2212x1672; 45° FOV; fundus photo: 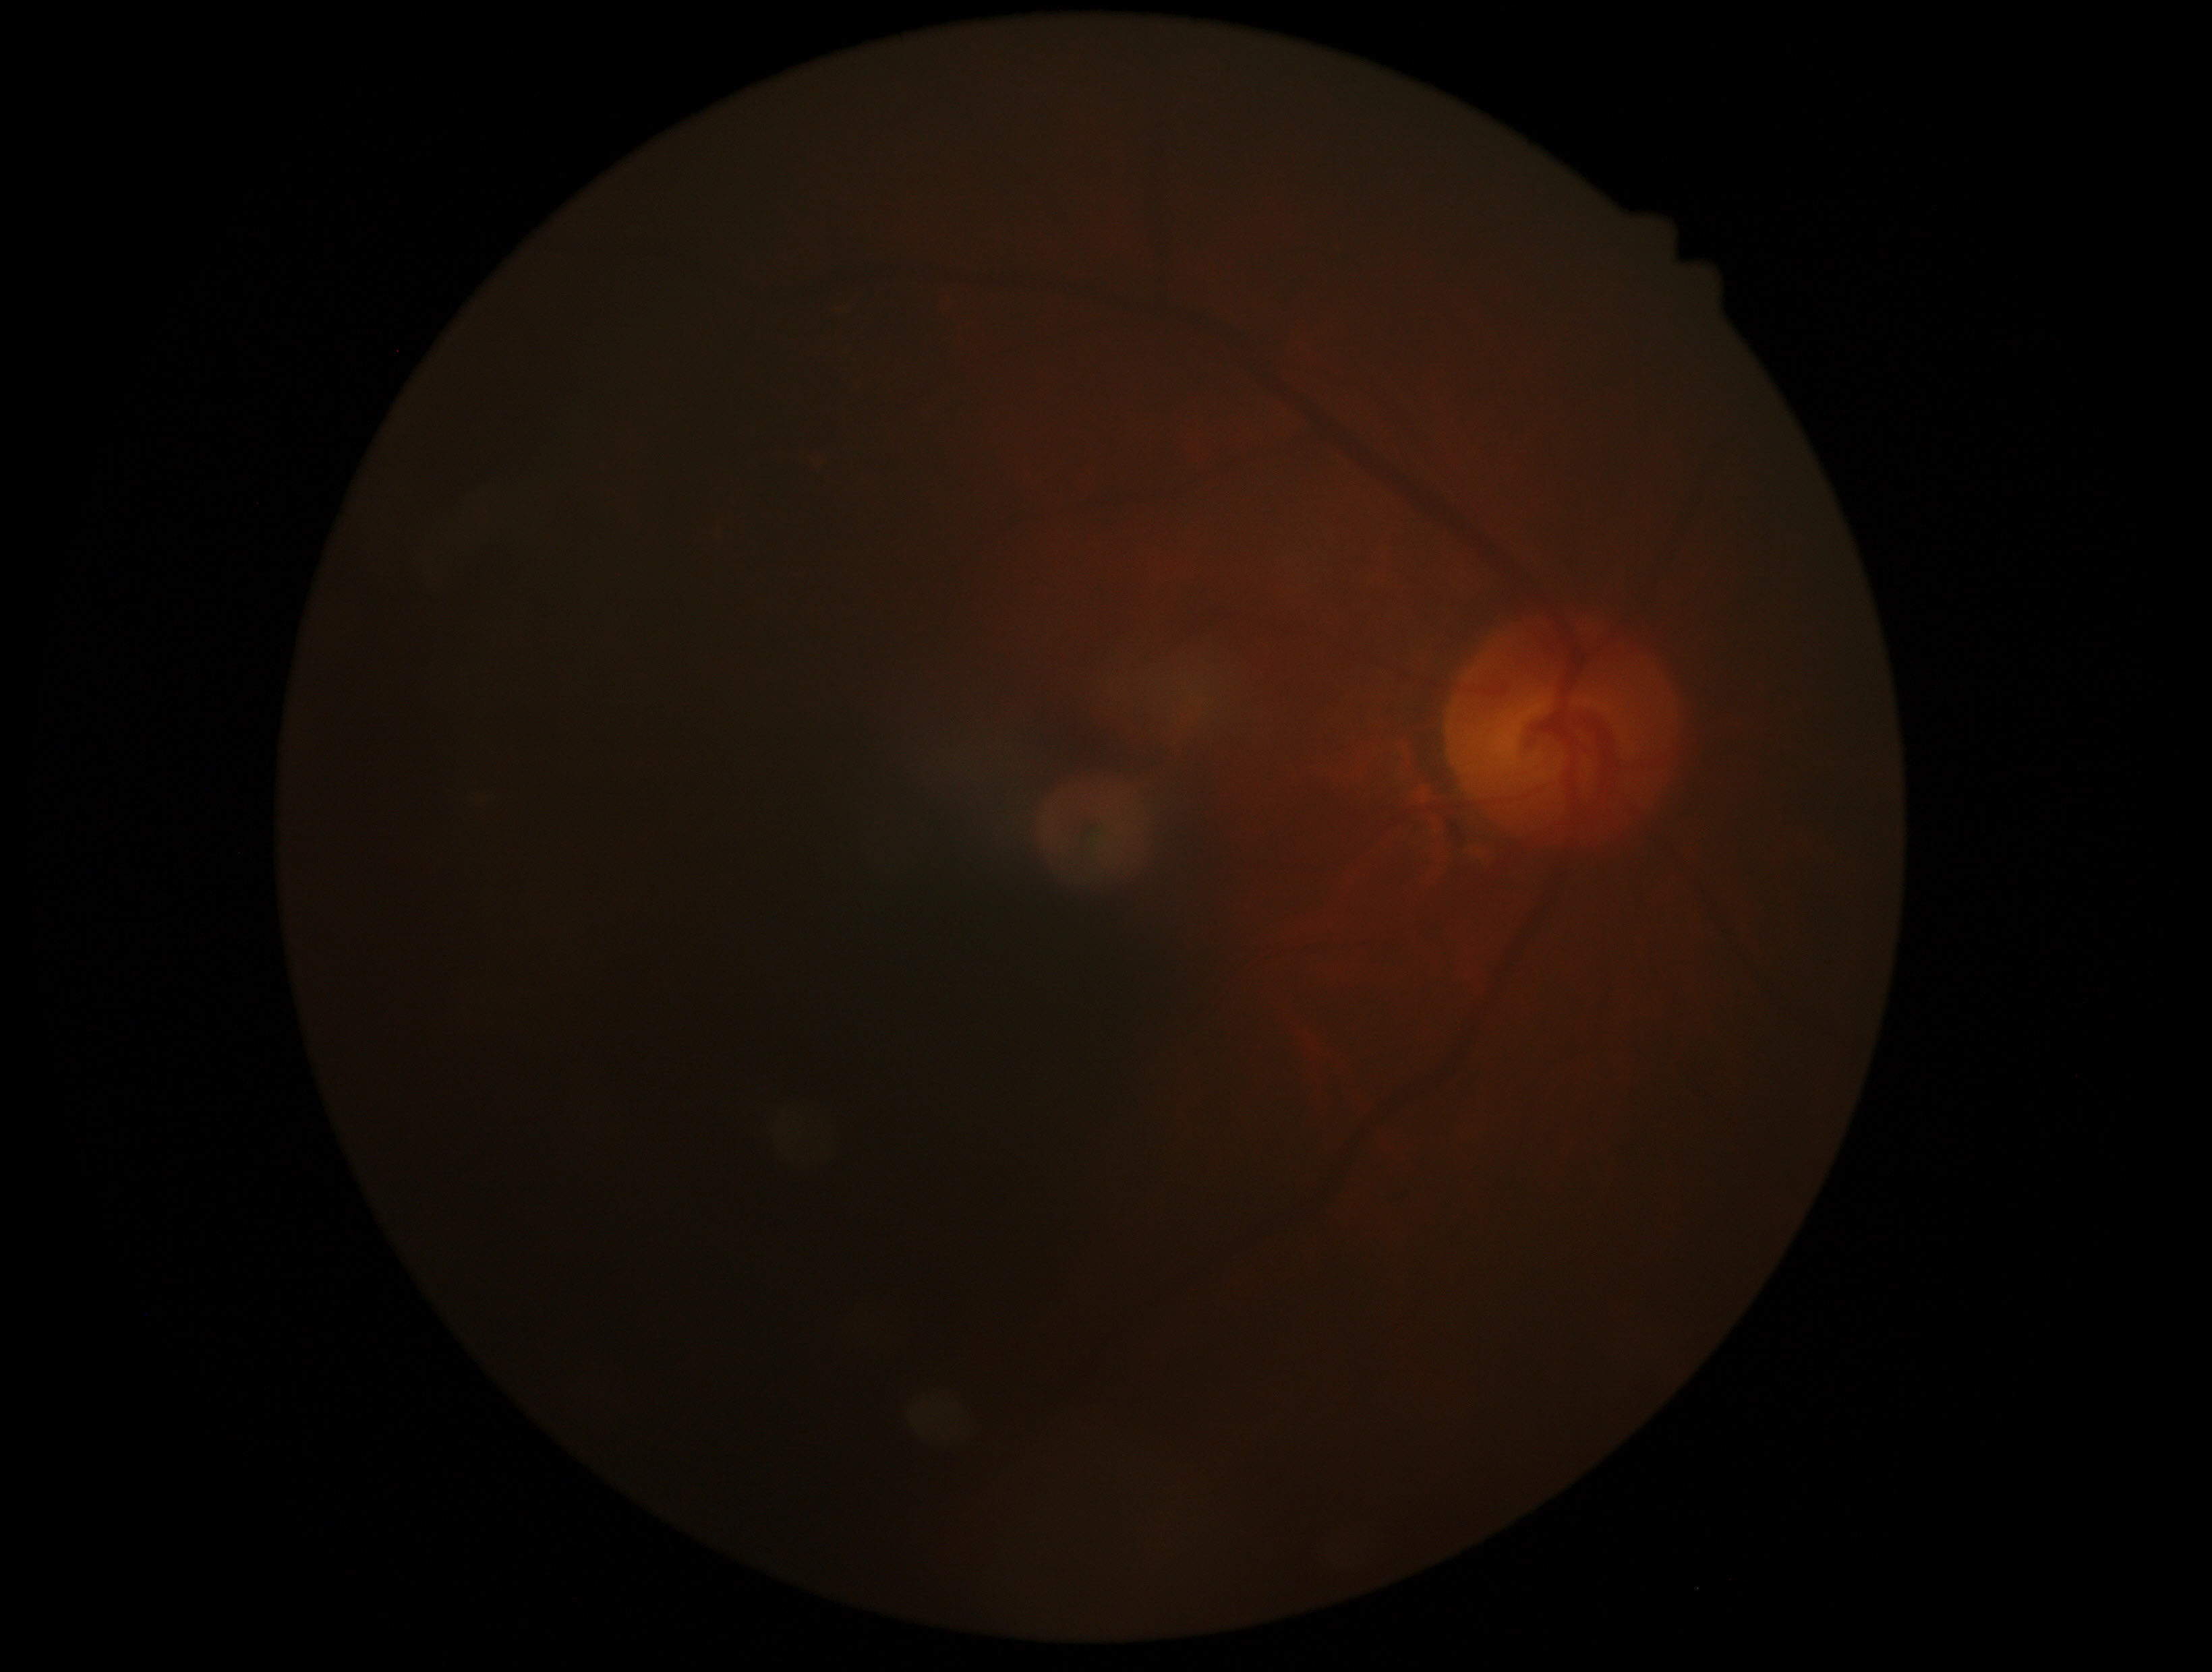
{
  "dr_grade": "ungradable due to poor image quality",
  "quality": "below grading threshold"
}